CFP, image size 1932x1932:
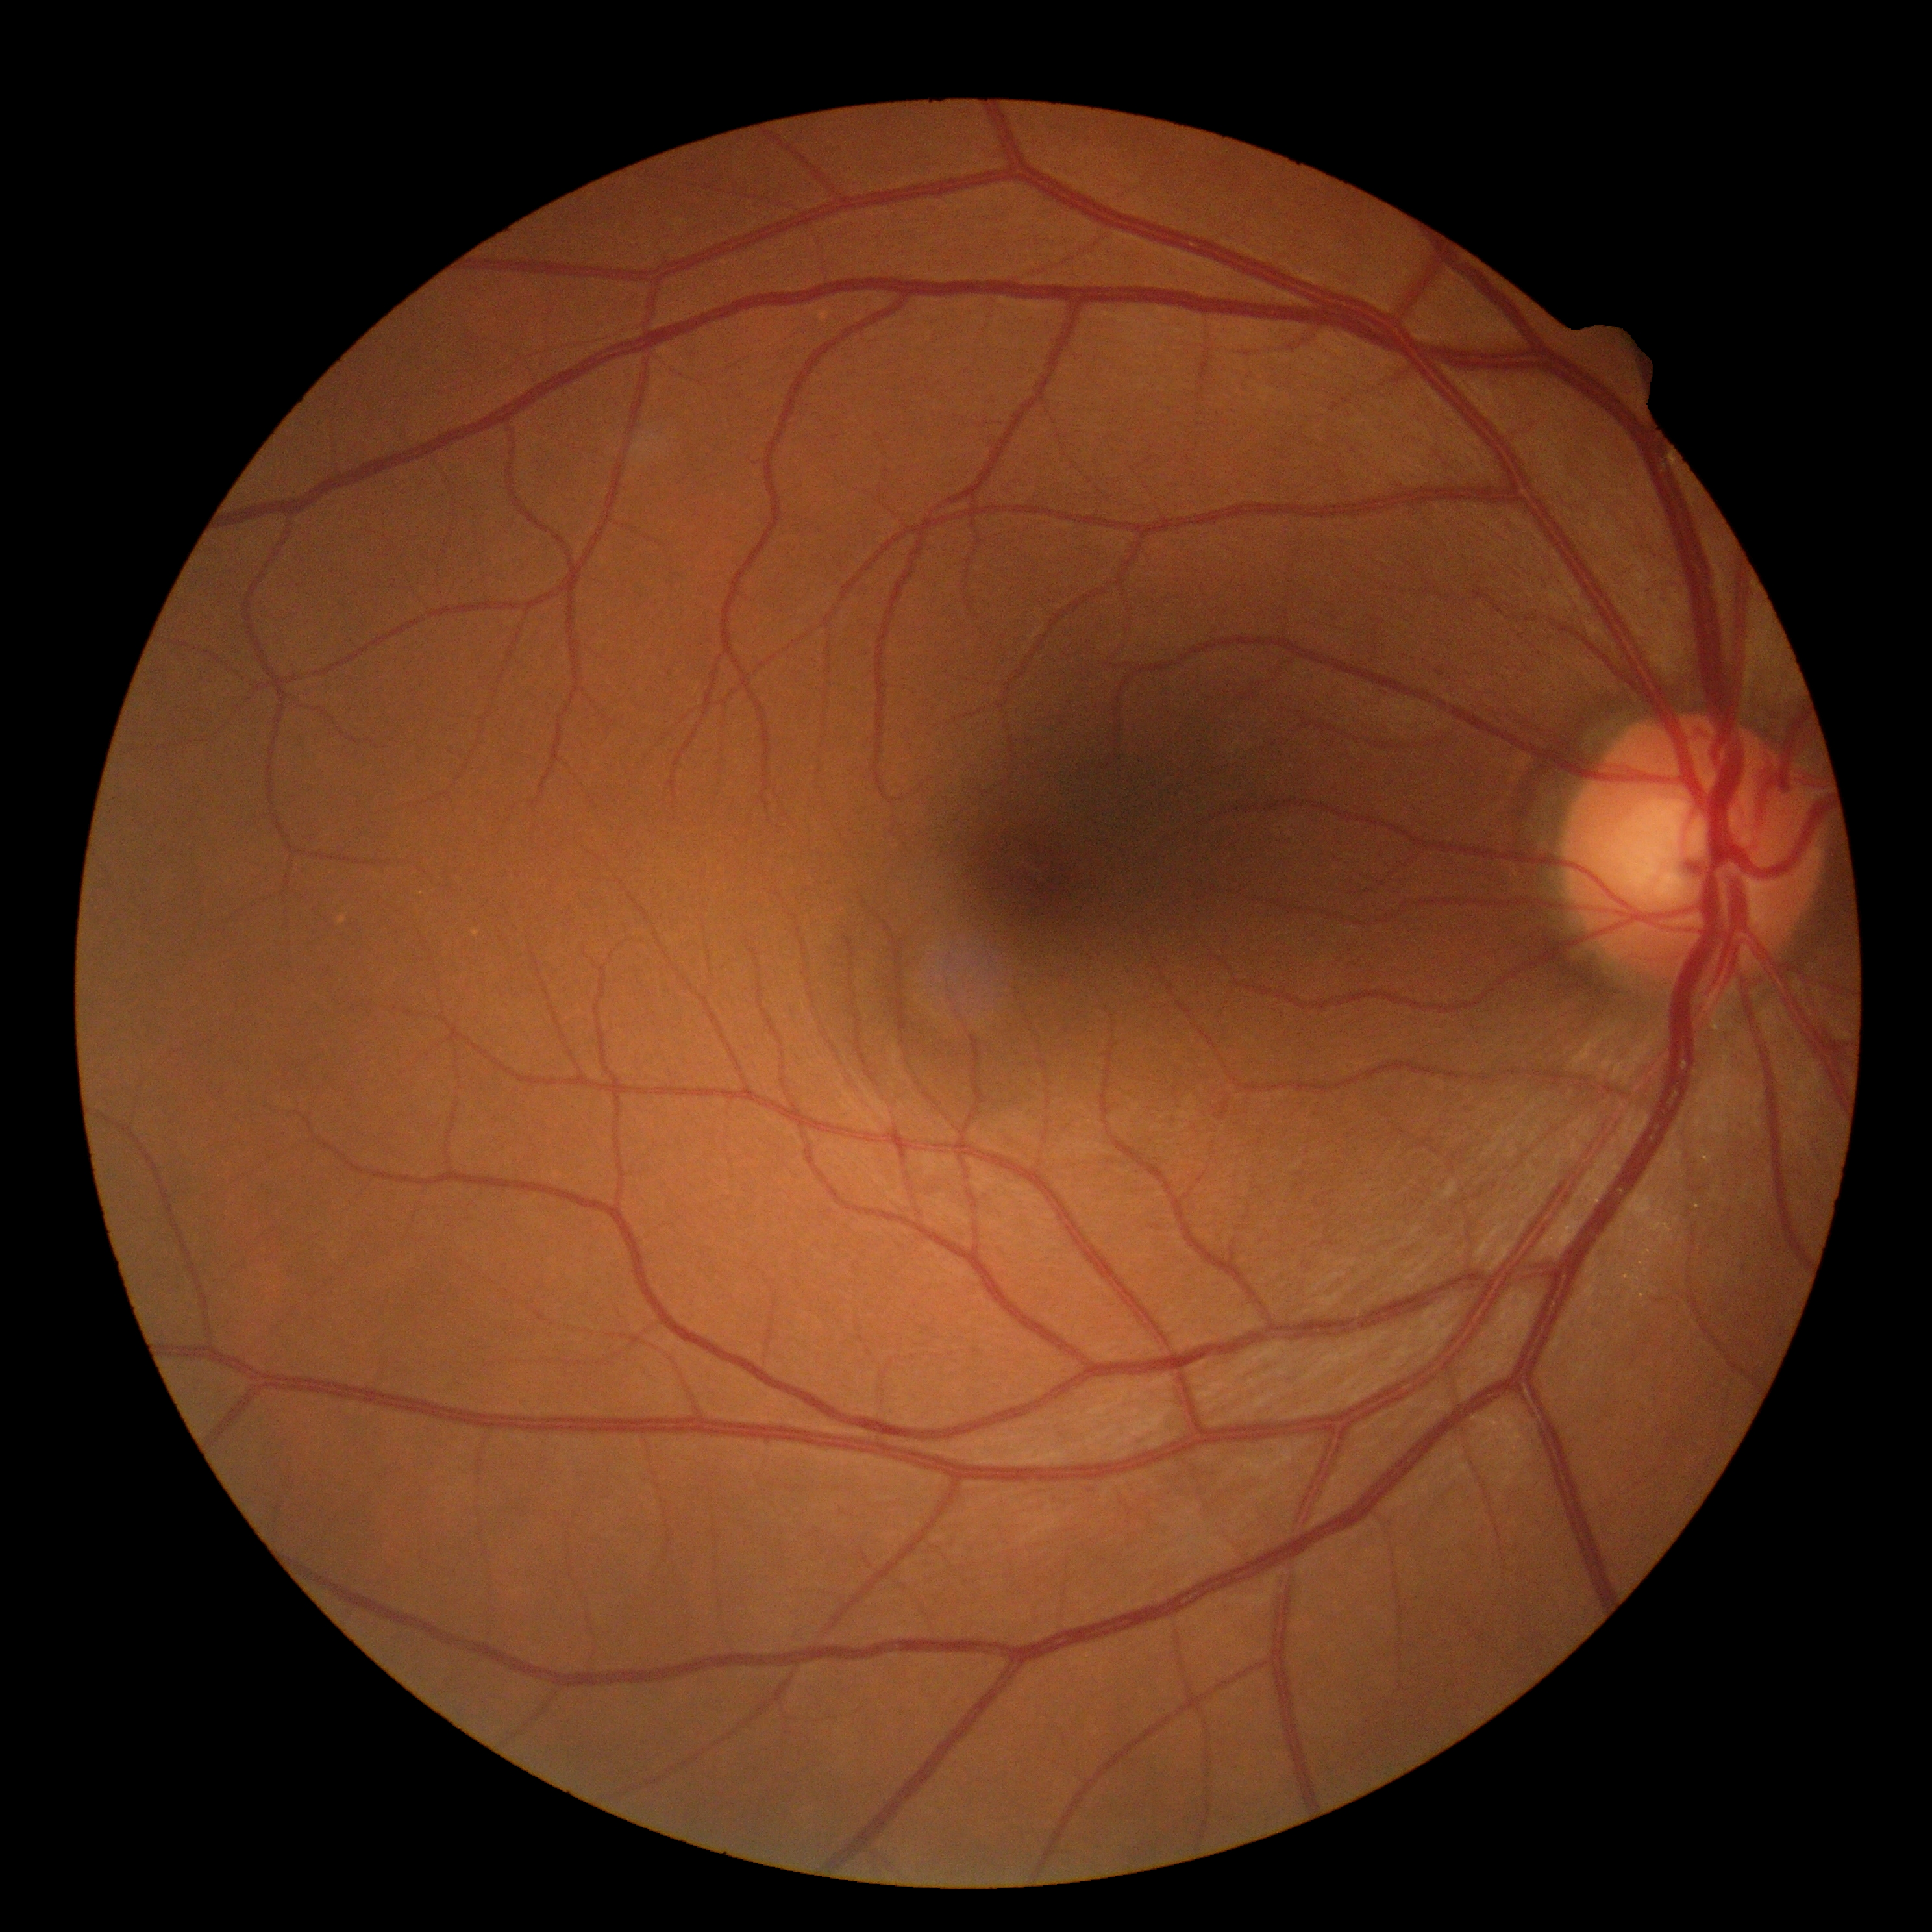

Findings:
– diabetic retinopathy (DR) — grade 0